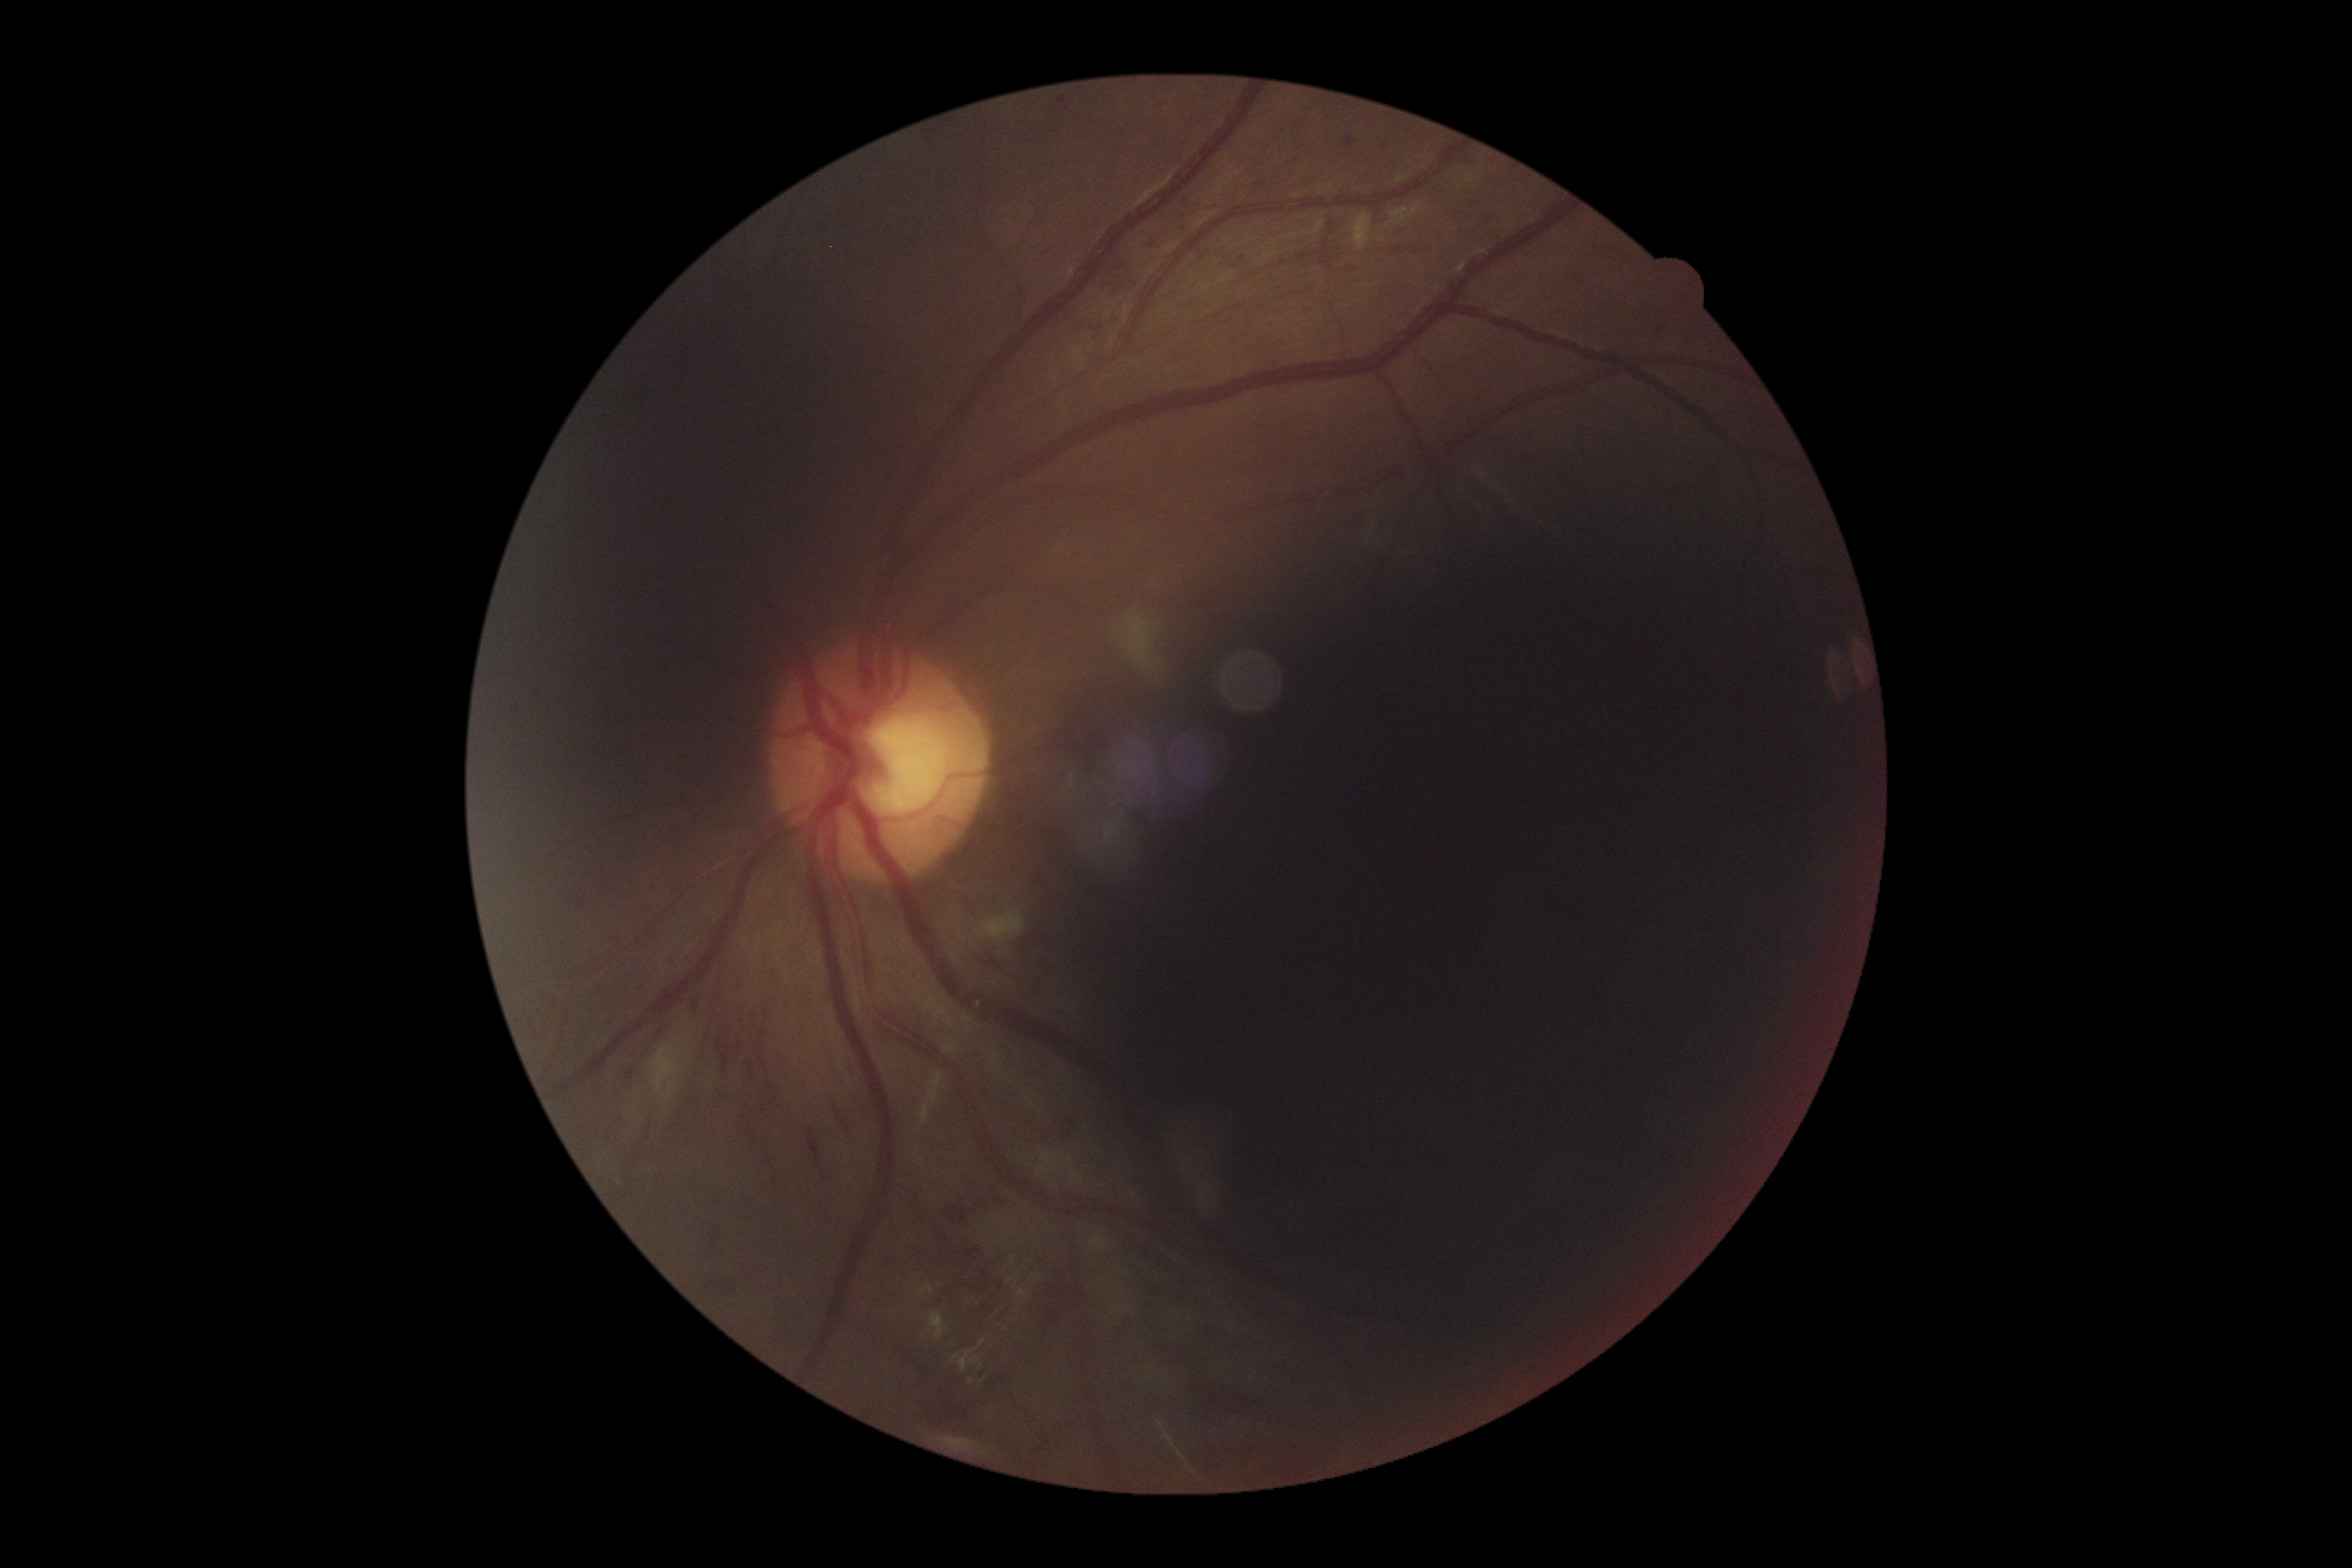 DR is 2.